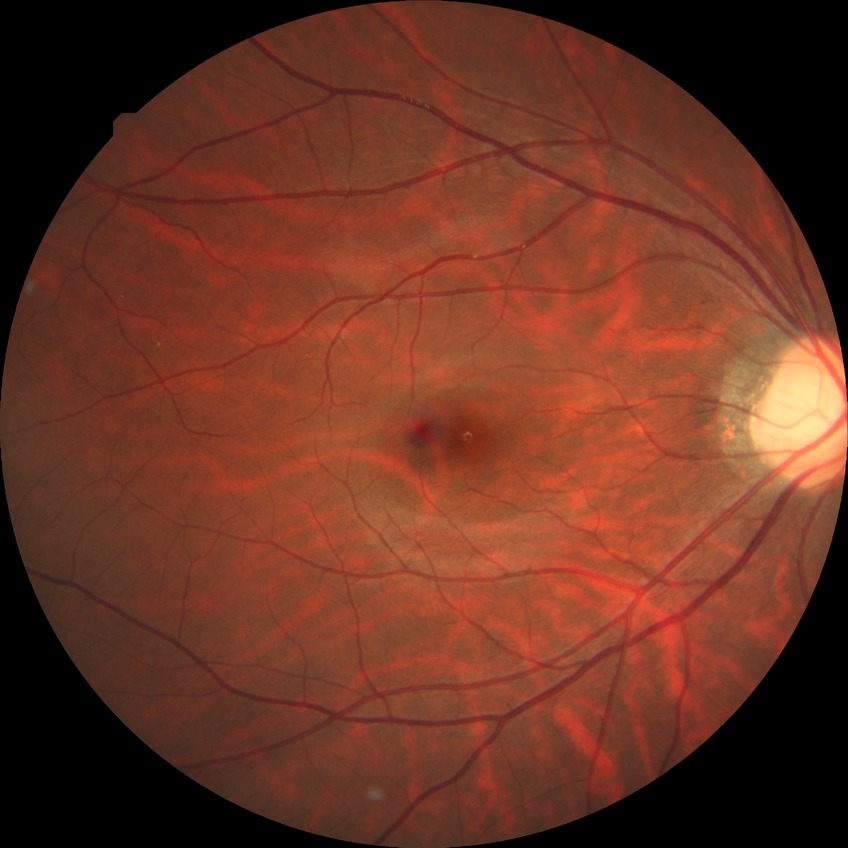 Diabetic retinopathy (DR): NDR (no diabetic retinopathy).